Retinal fundus photograph: 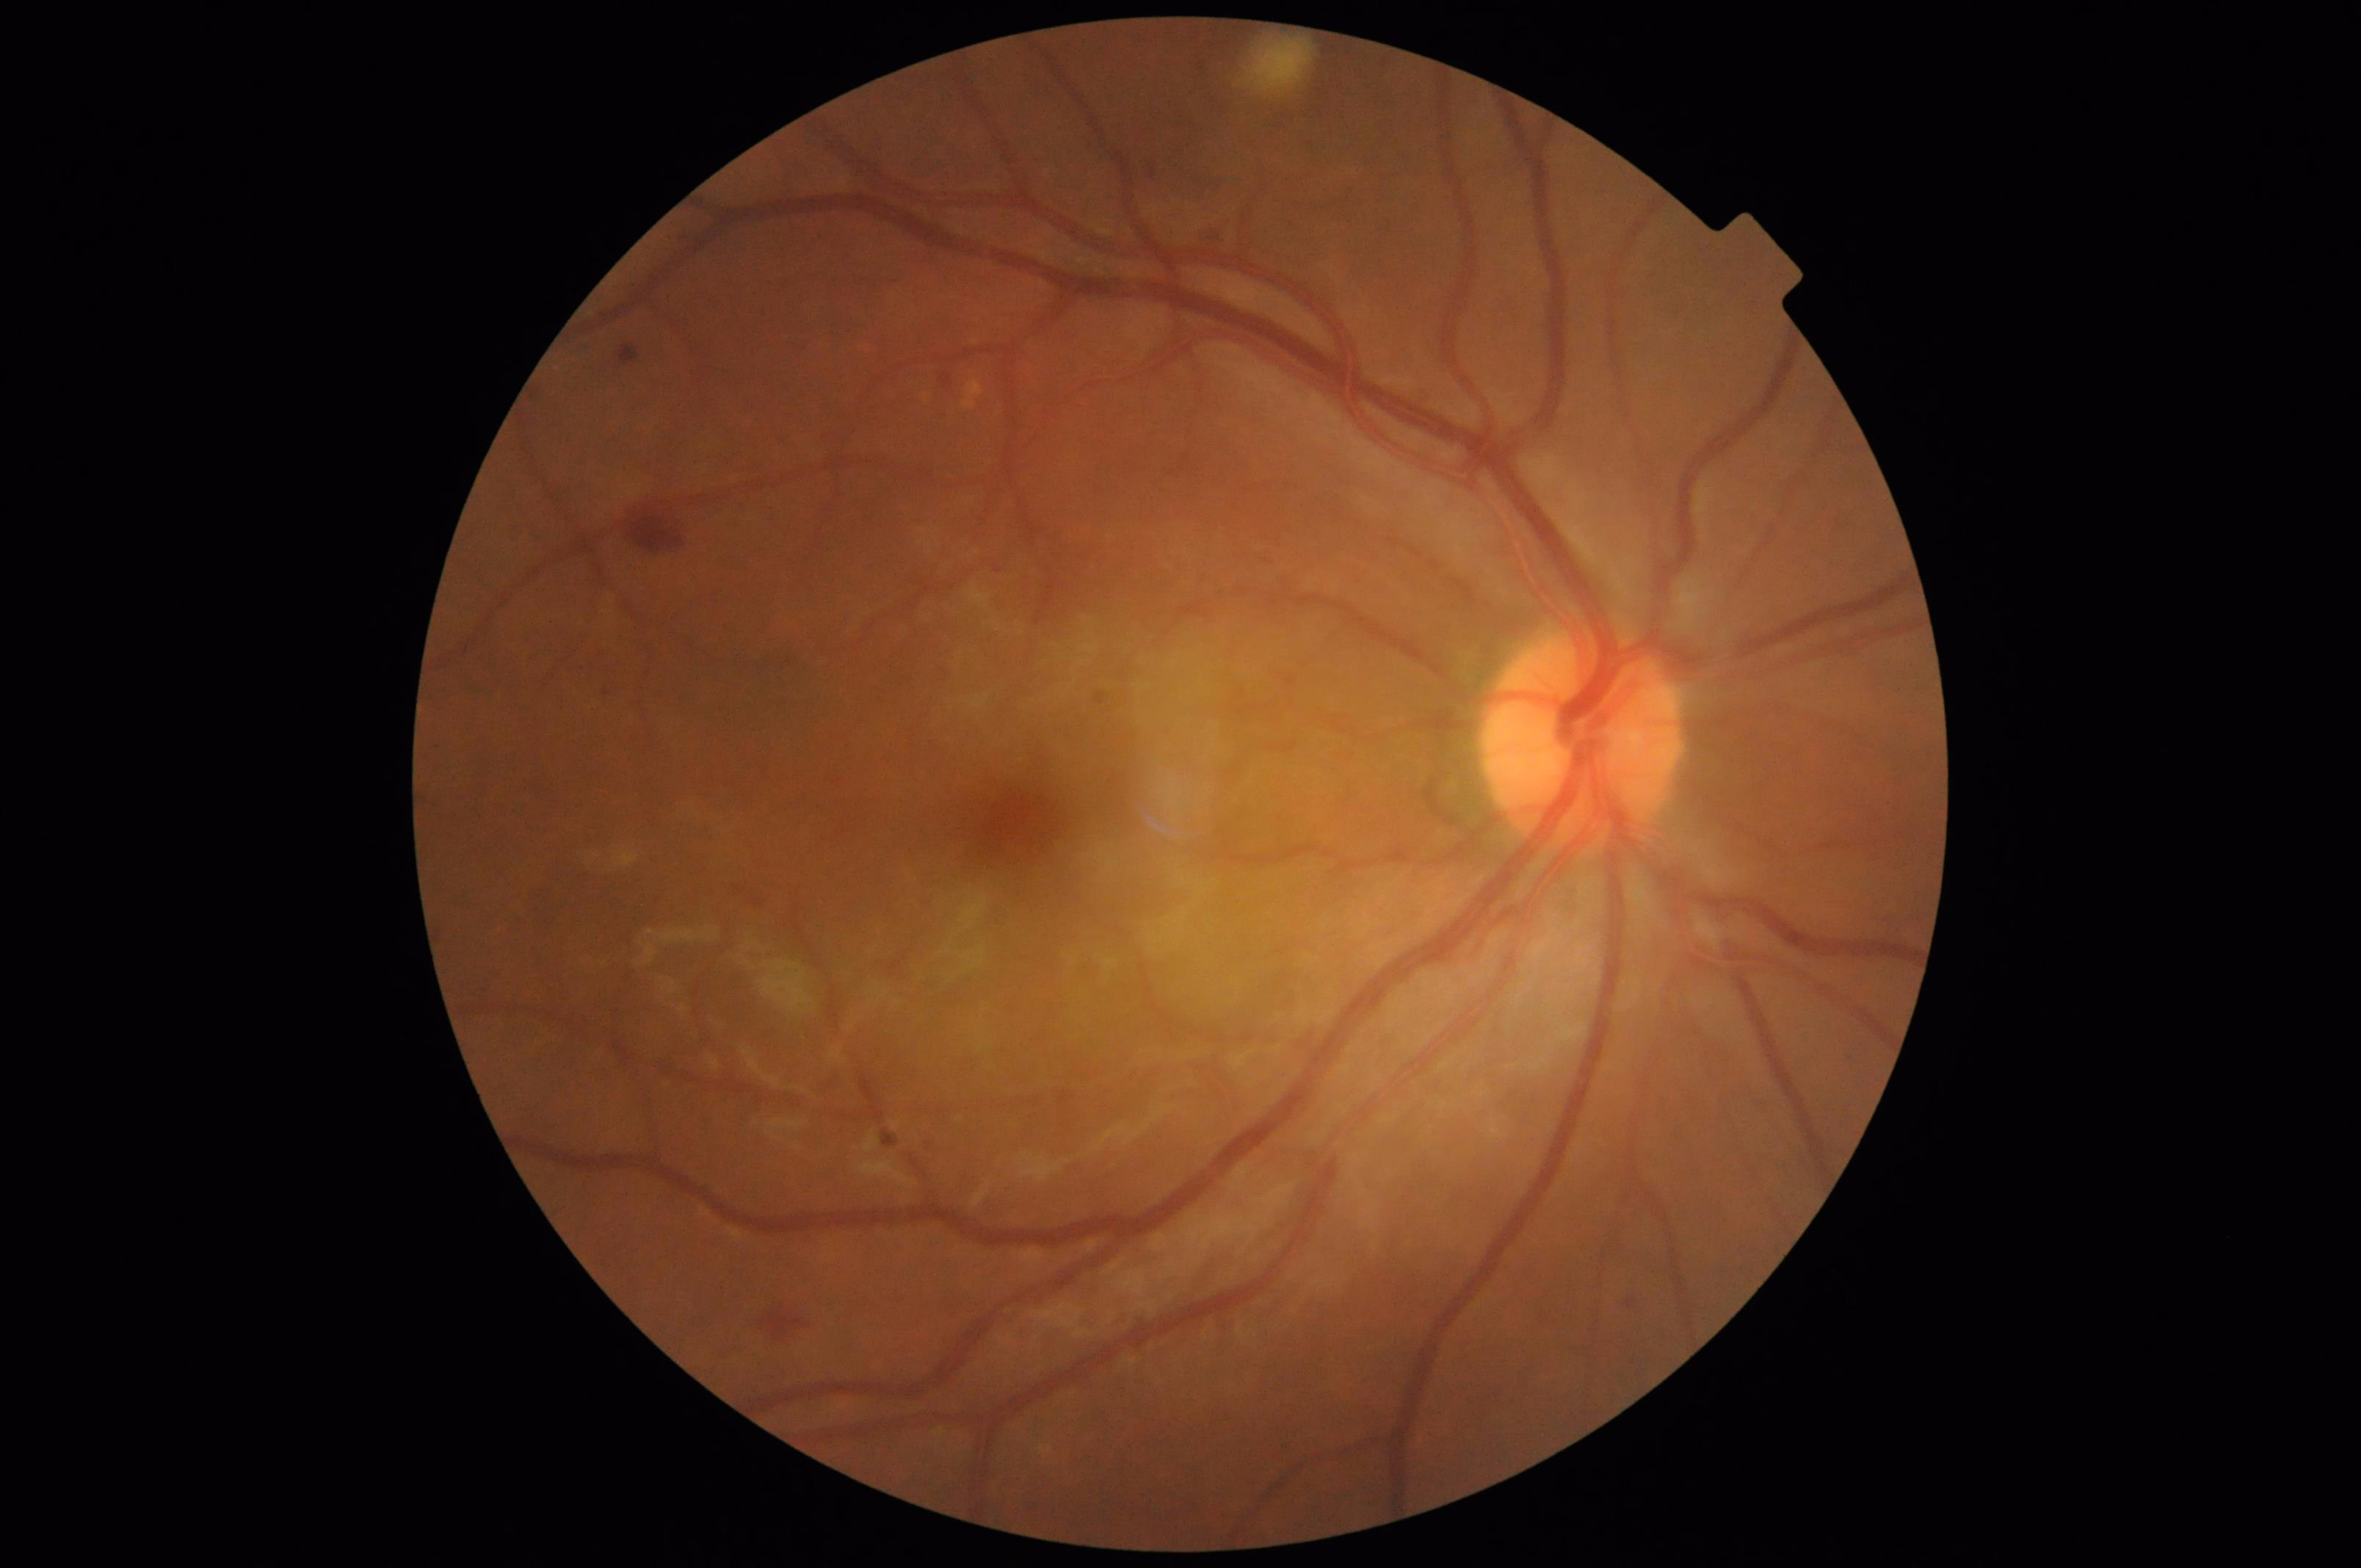
{
  "contrast": "adequate",
  "overall_quality": "adequate",
  "illumination": "adequate",
  "clarity": "sharp"
}